45° field of view, image size 848x848, CFP
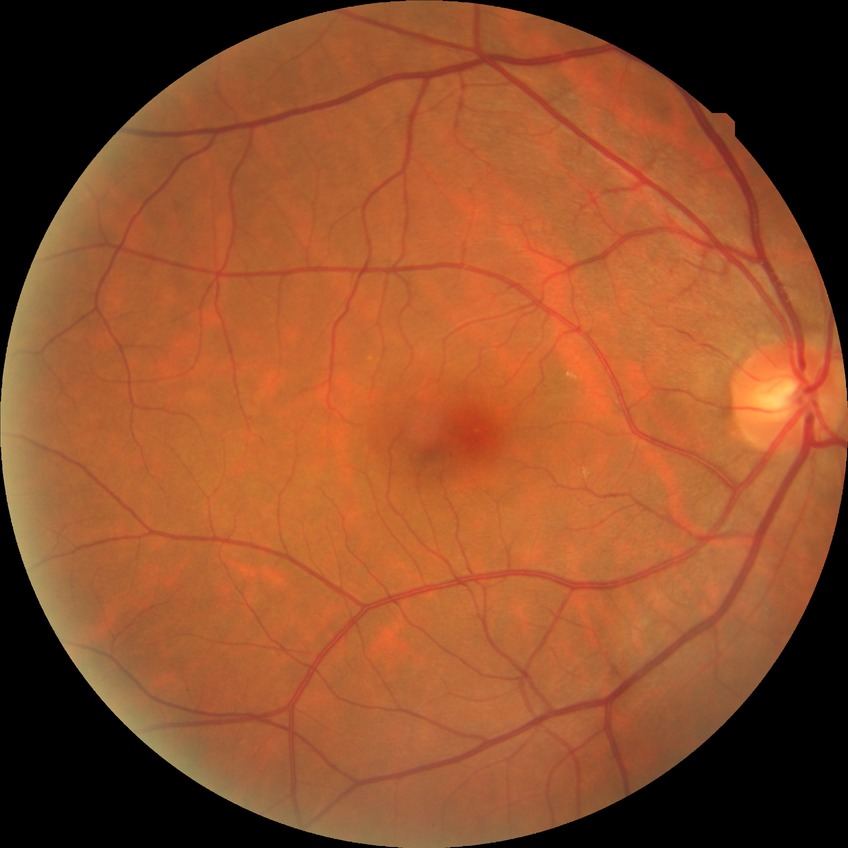 Diabetic retinopathy (DR): no diabetic retinopathy (NDR).